Without pupil dilation. Diabetic retinopathy graded by the modified Davis classification.
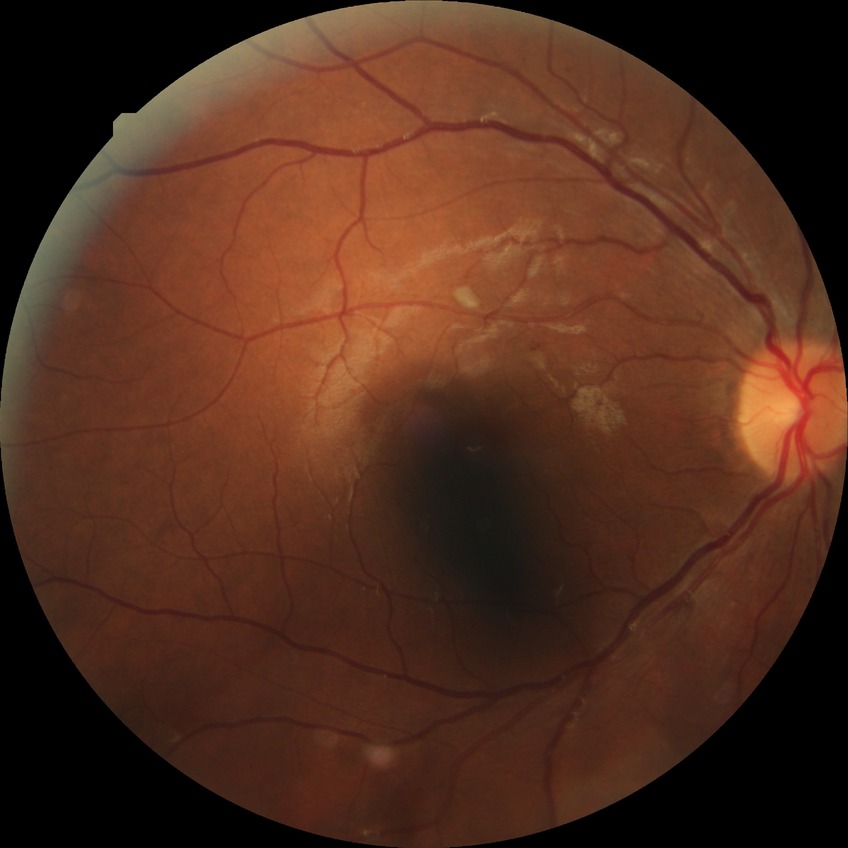

DR severity: SDR.